Fundus photo
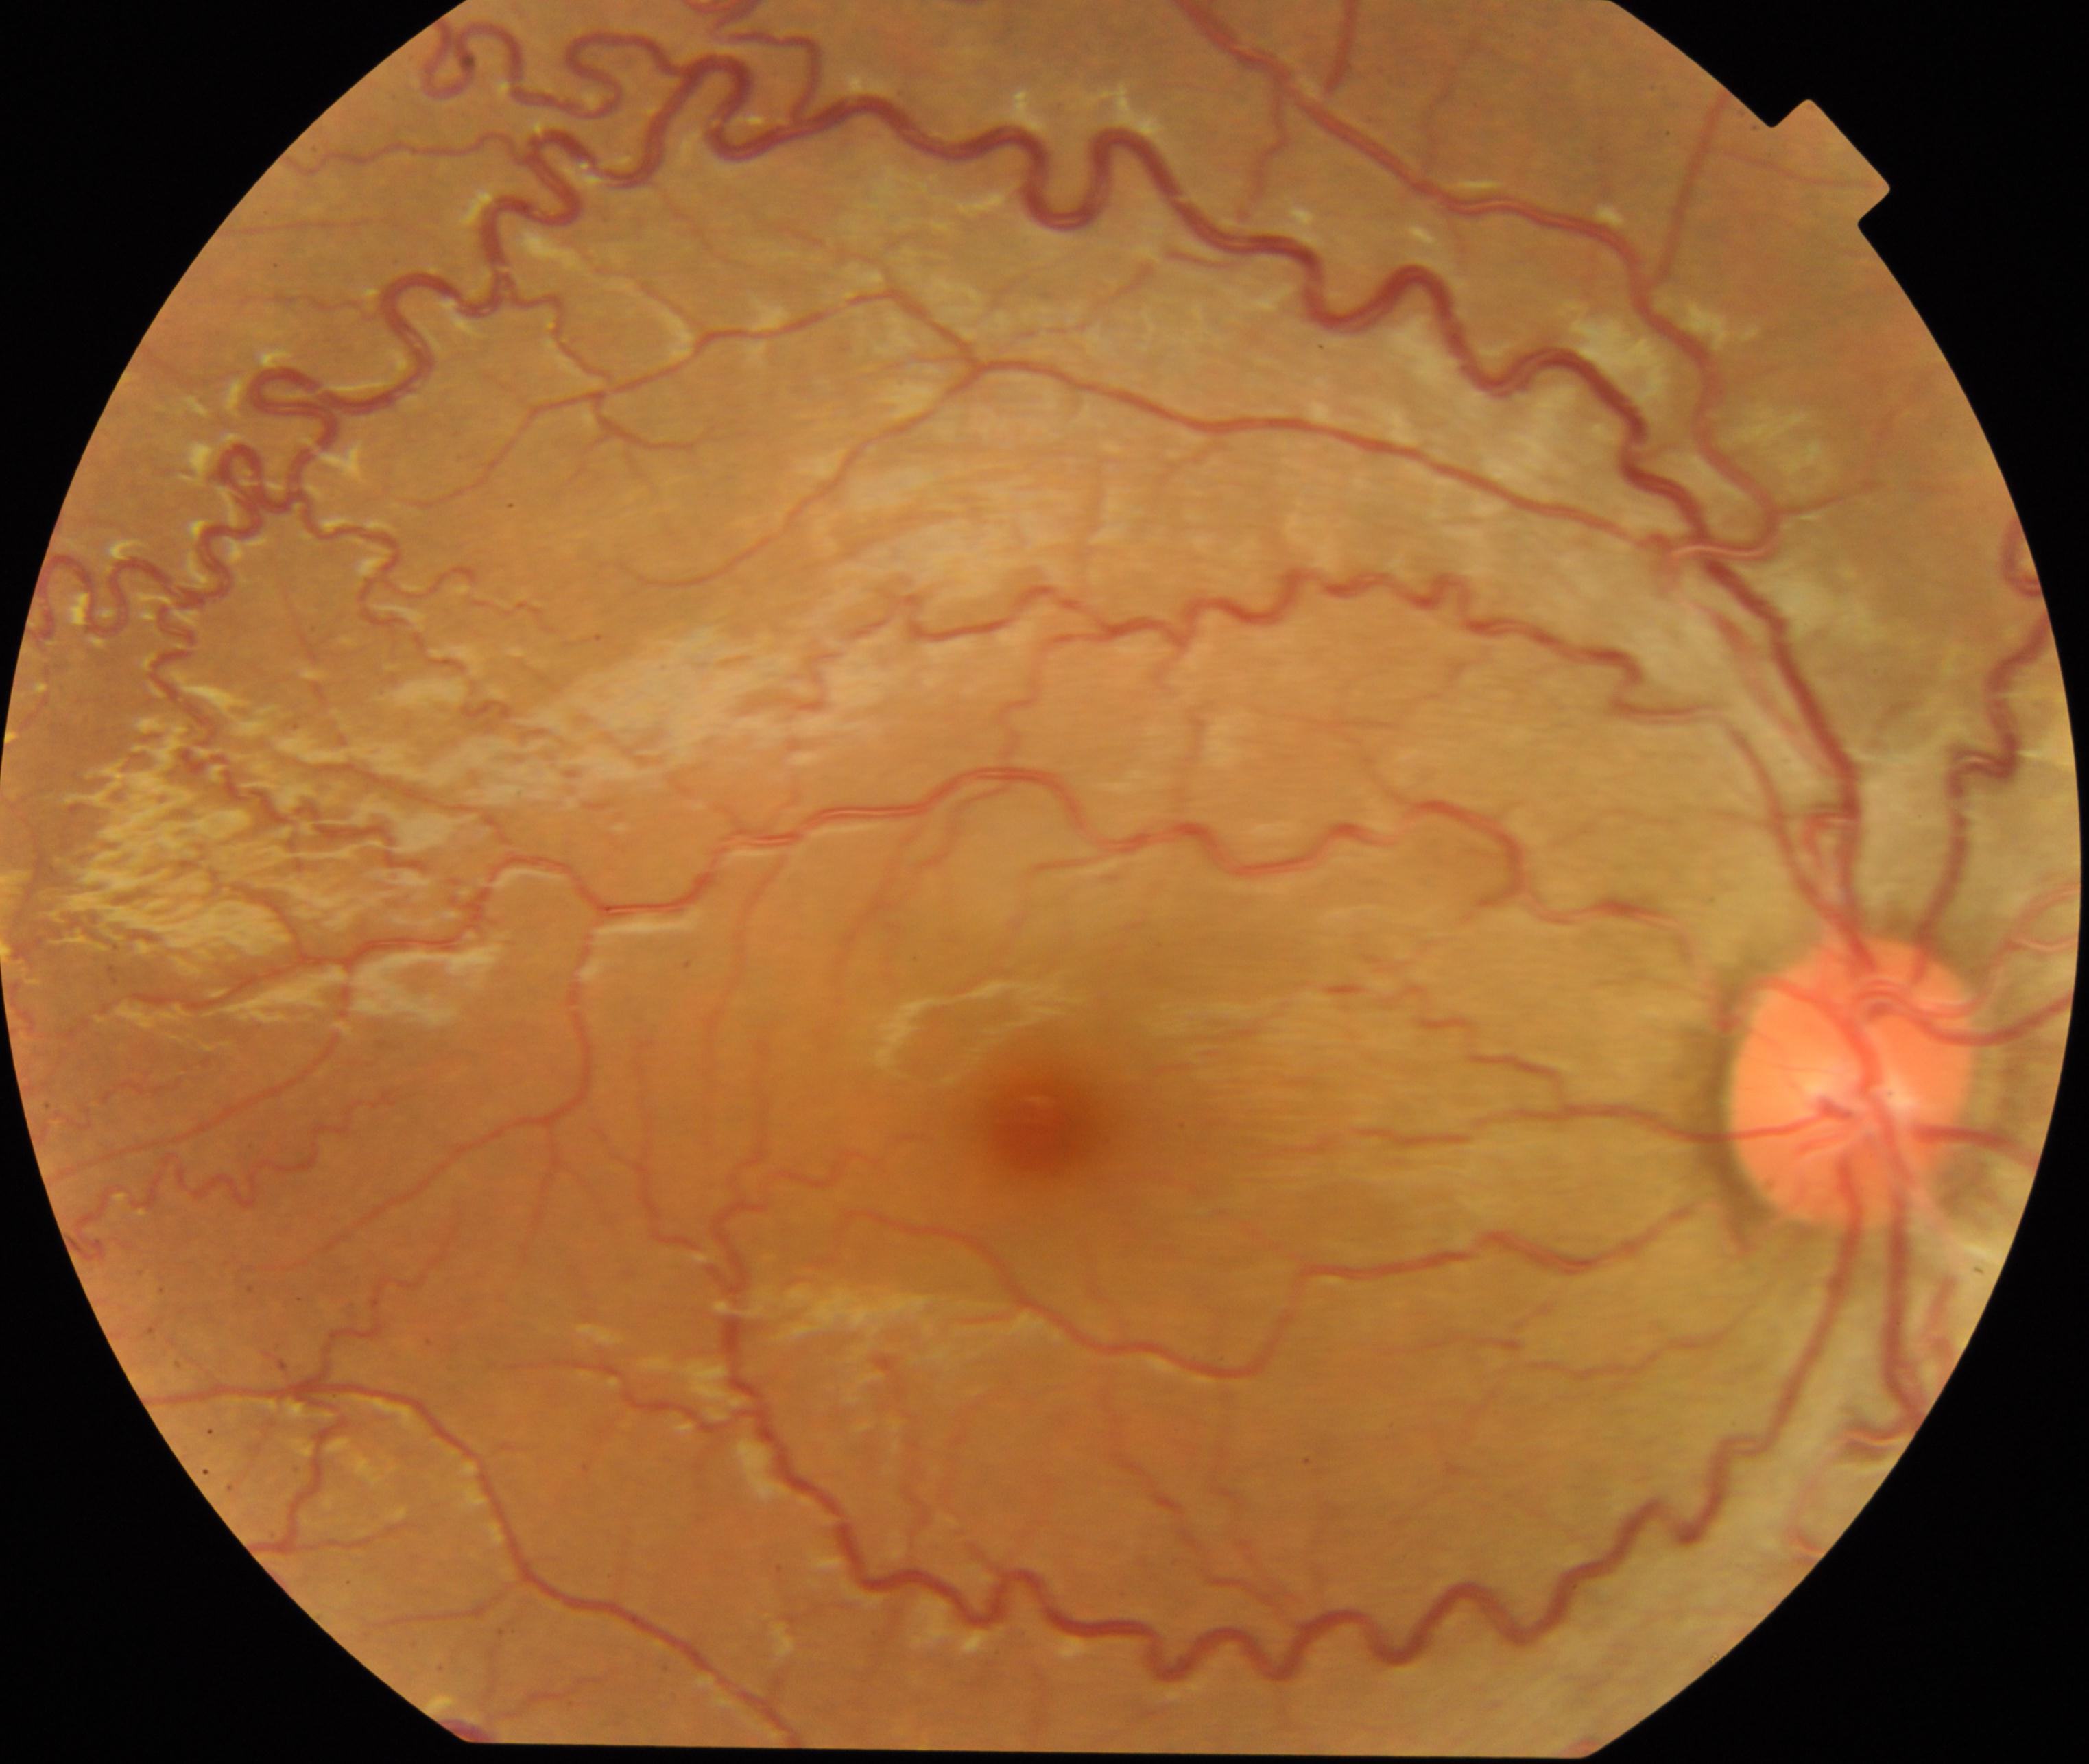

Primary finding: vessel tortuosity.